Pediatric wide-field fundus photograph. Image size 1240x1240
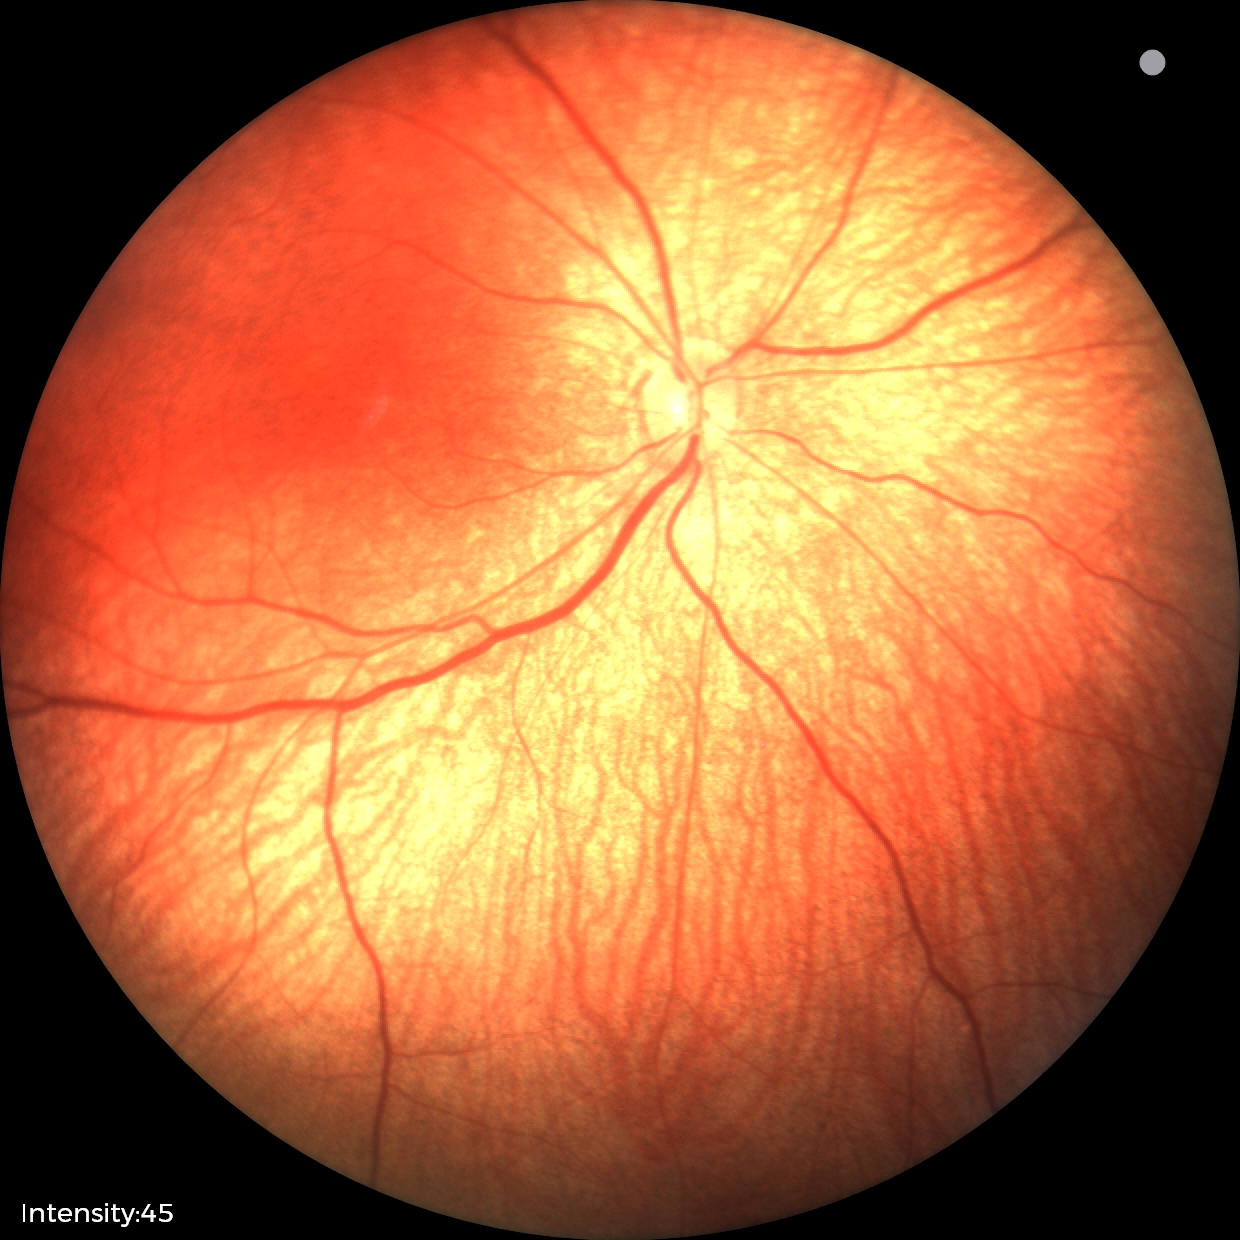

Impression: no abnormal retinal findings.